Graded on the modified Davis scale
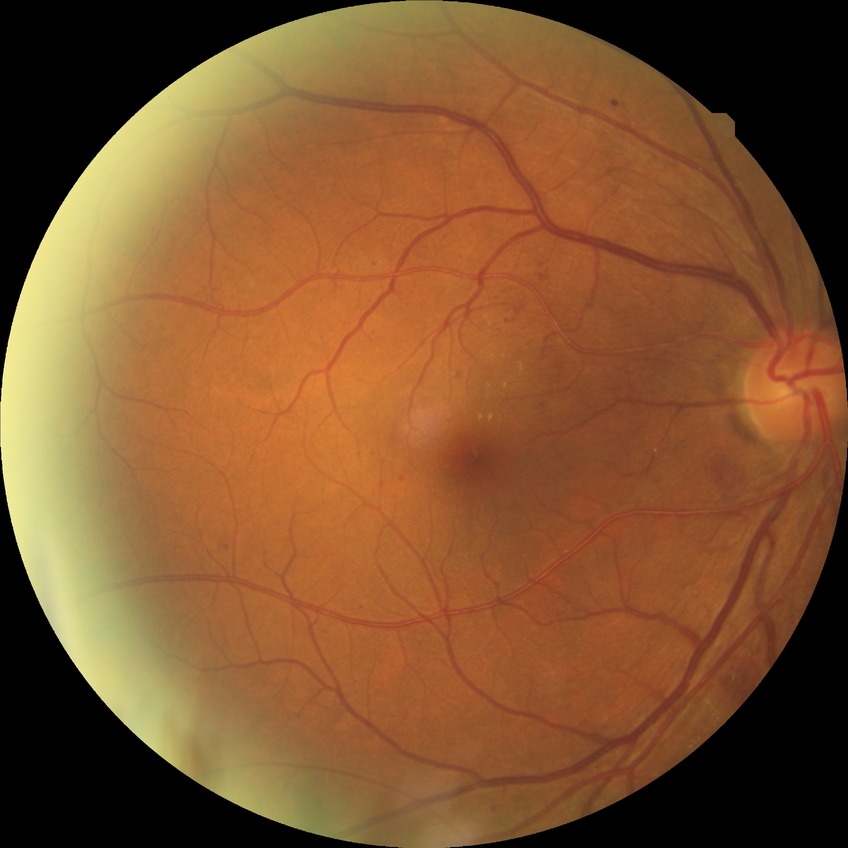 Diabetic retinopathy (DR): pre-proliferative diabetic retinopathy (PPDR). DR class: non-proliferative diabetic retinopathy.